848x848px. 45° FOV. Without pupil dilation: 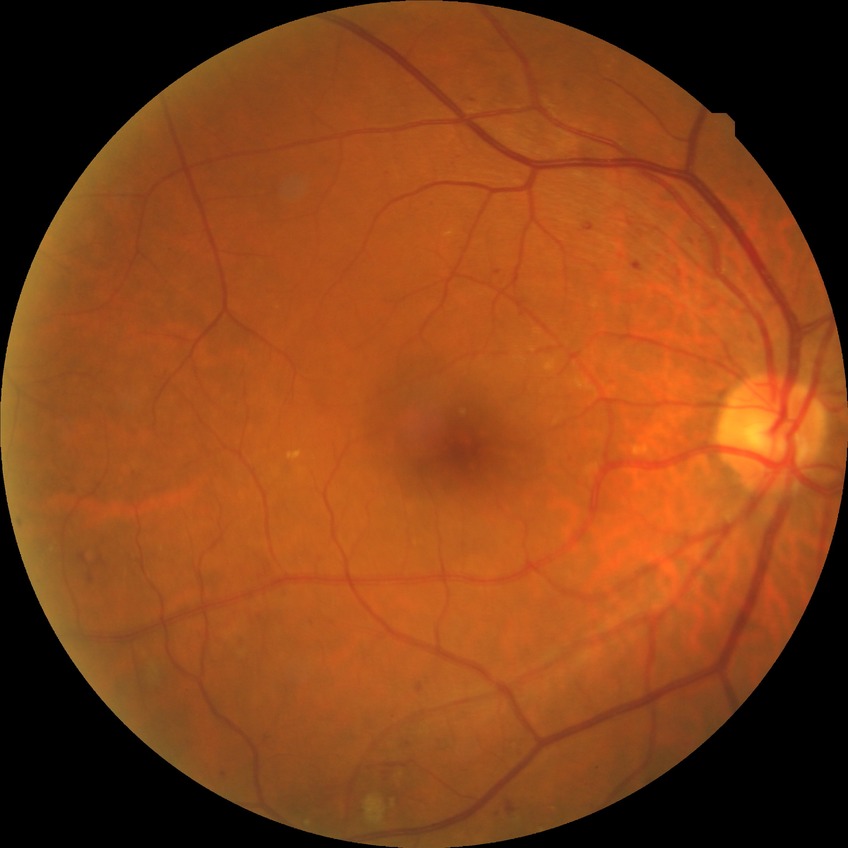
diabetic retinopathy (DR): SDR (simple diabetic retinopathy).